45° FOV; color fundus image — 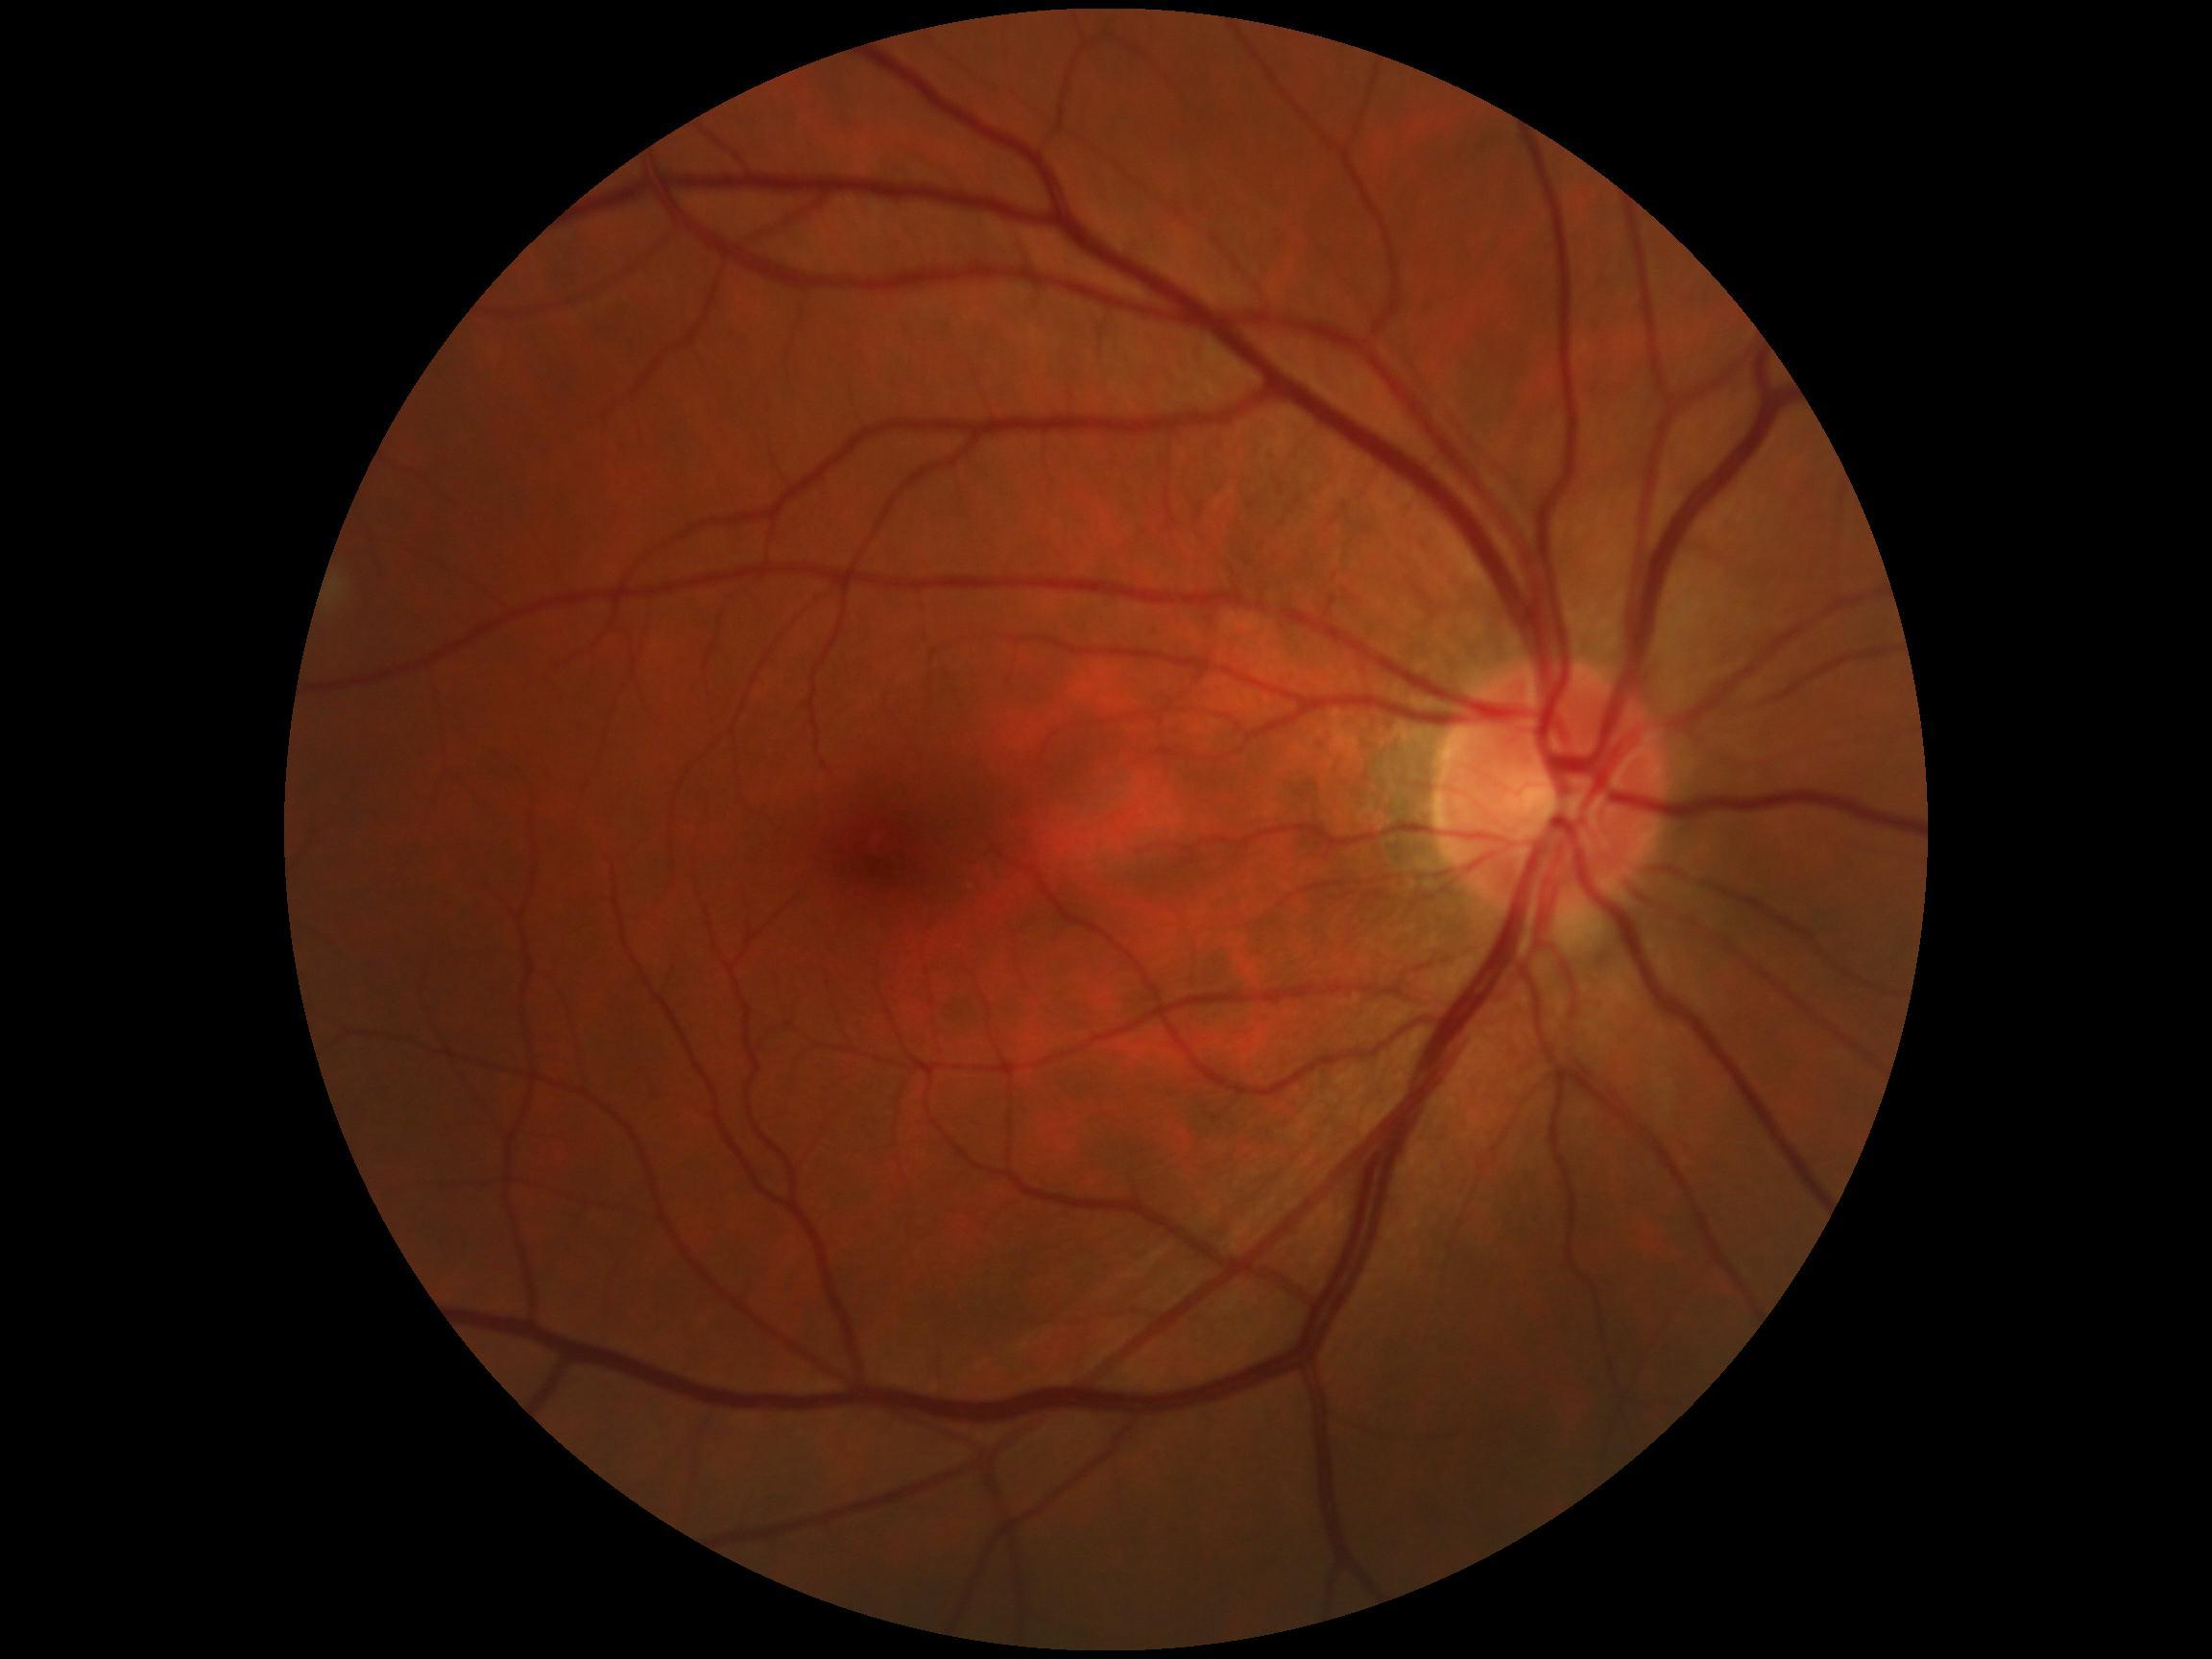
DR grade@0 — no visible signs of diabetic retinopathy, DR impression@no DR findings.